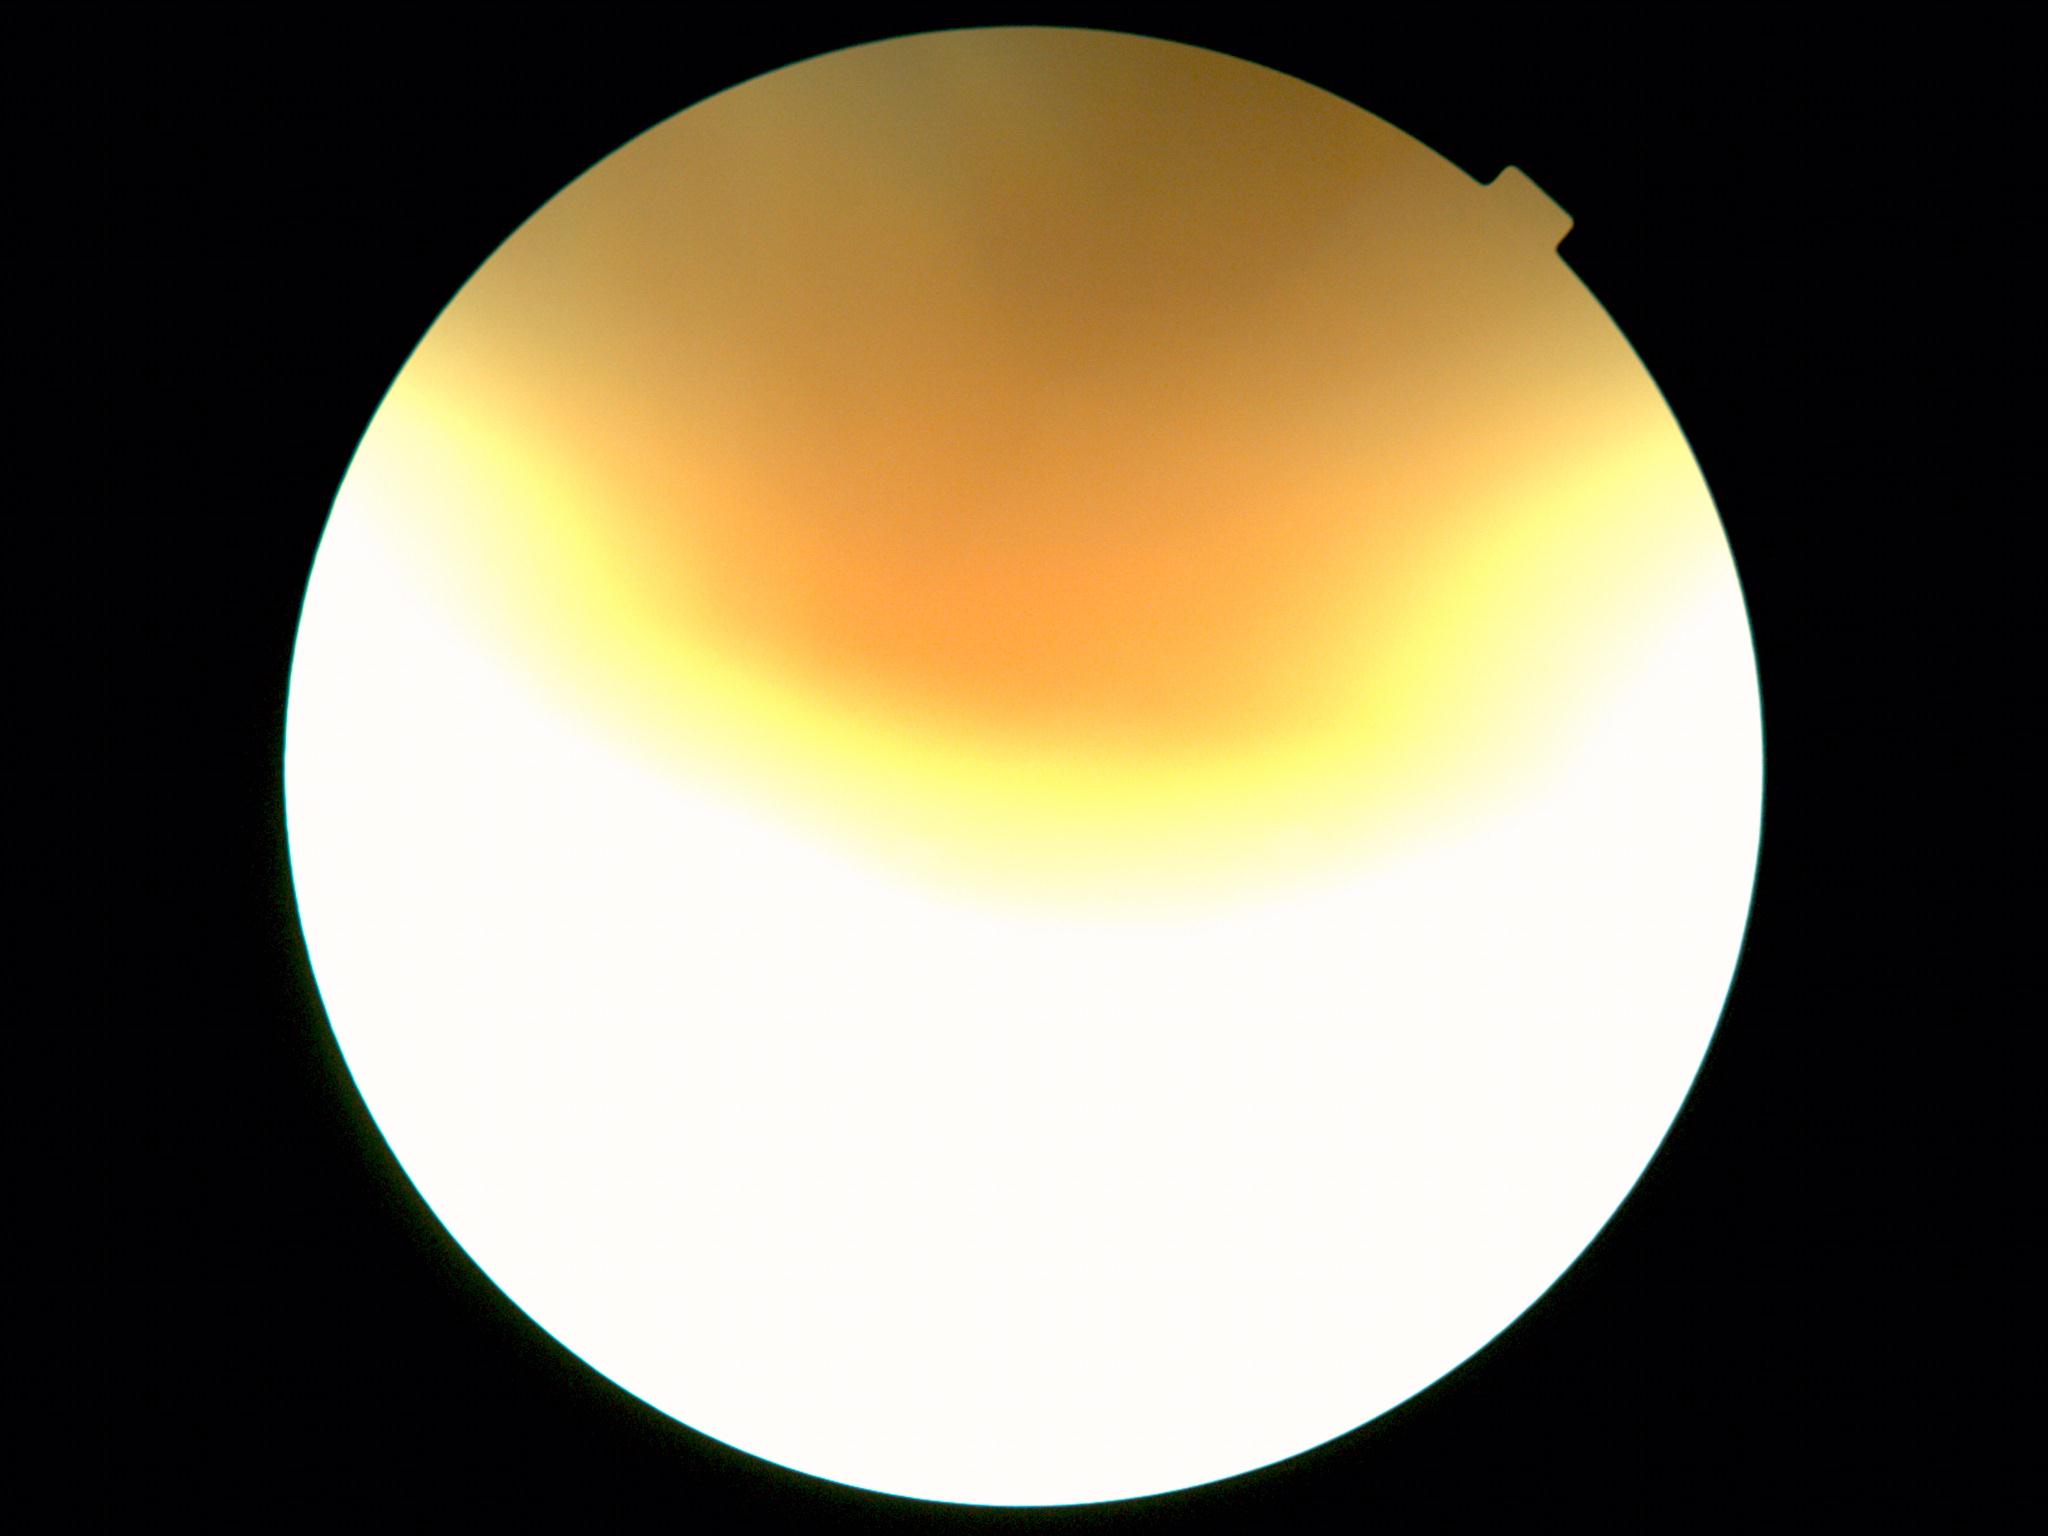
The image cannot be graded for diabetic retinopathy. Diabetic retinopathy: ungradable.